Acquired with a NIDEK AFC-230:
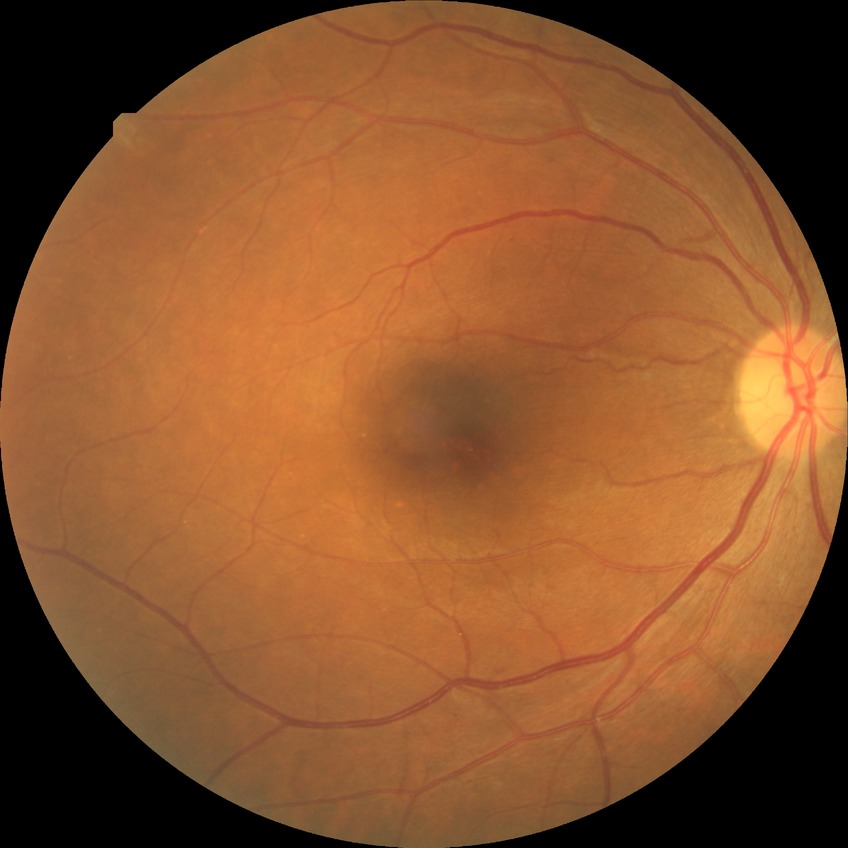 Davis grading is simple diabetic retinopathy.